Color fundus image
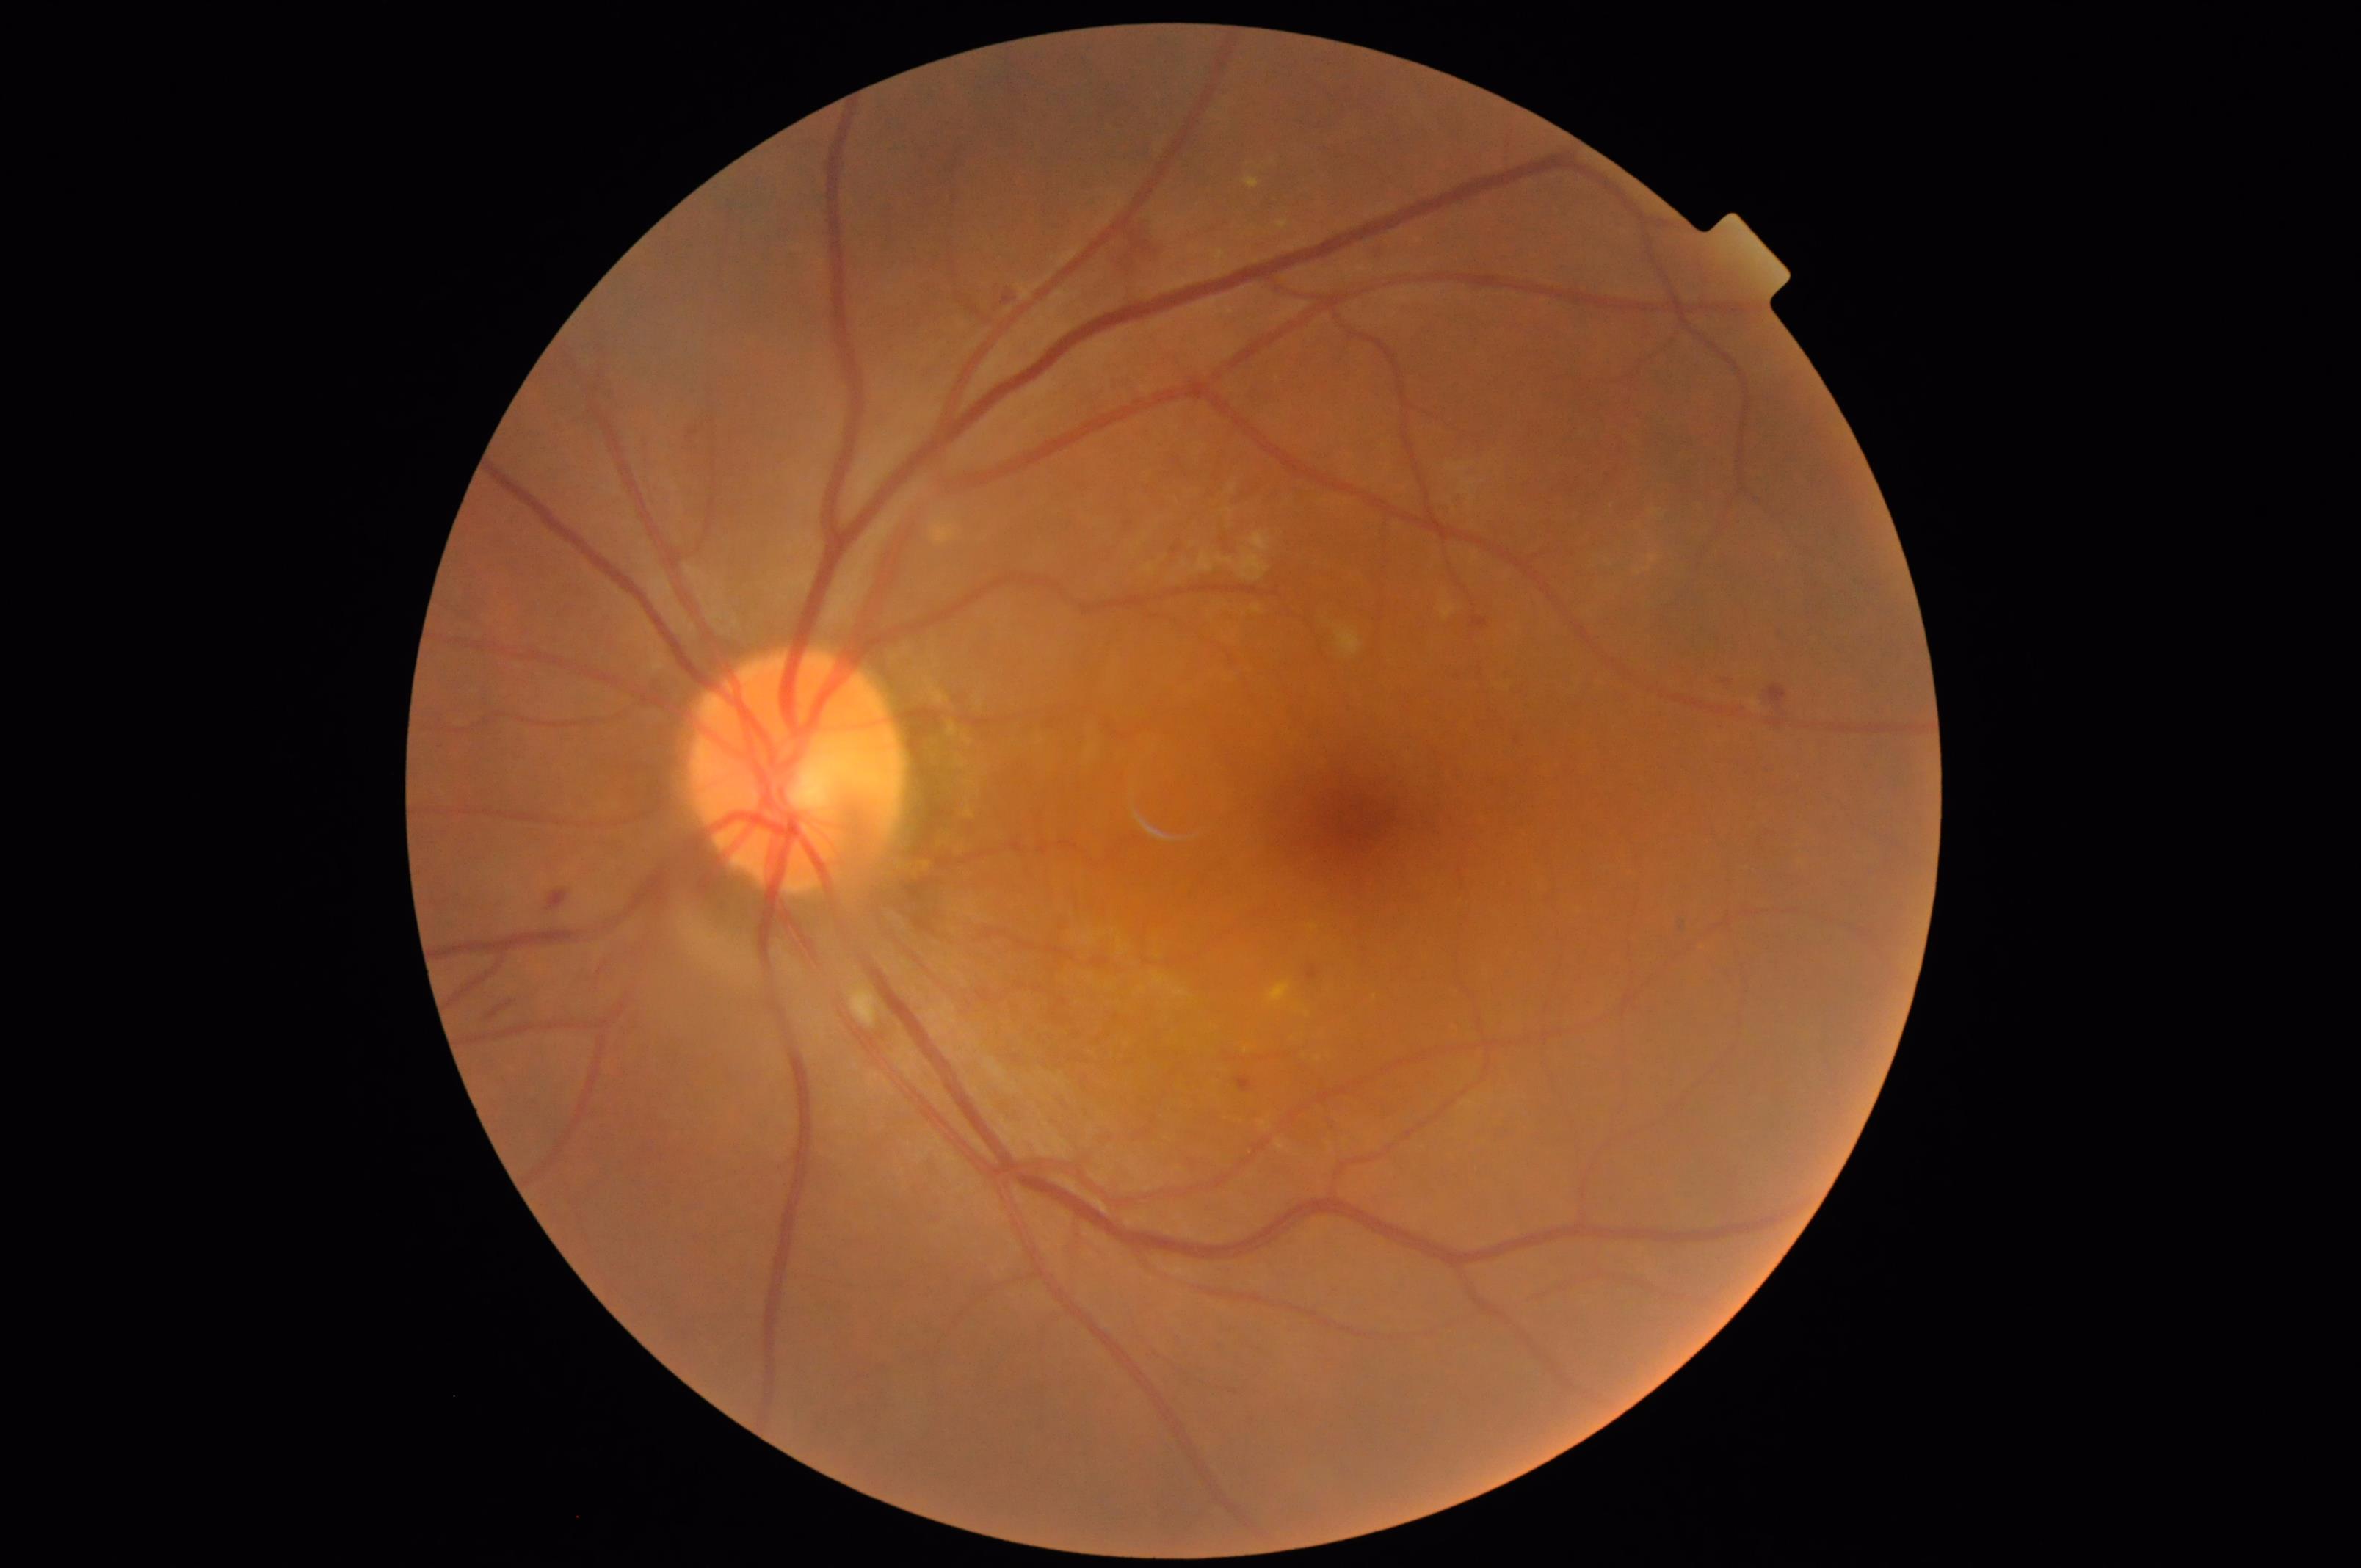 Good dynamic range. Image quality is adequate for diagnostic use. The image is clear.